Acquired with a Topcon TRC-NW8 · centered on the macula:
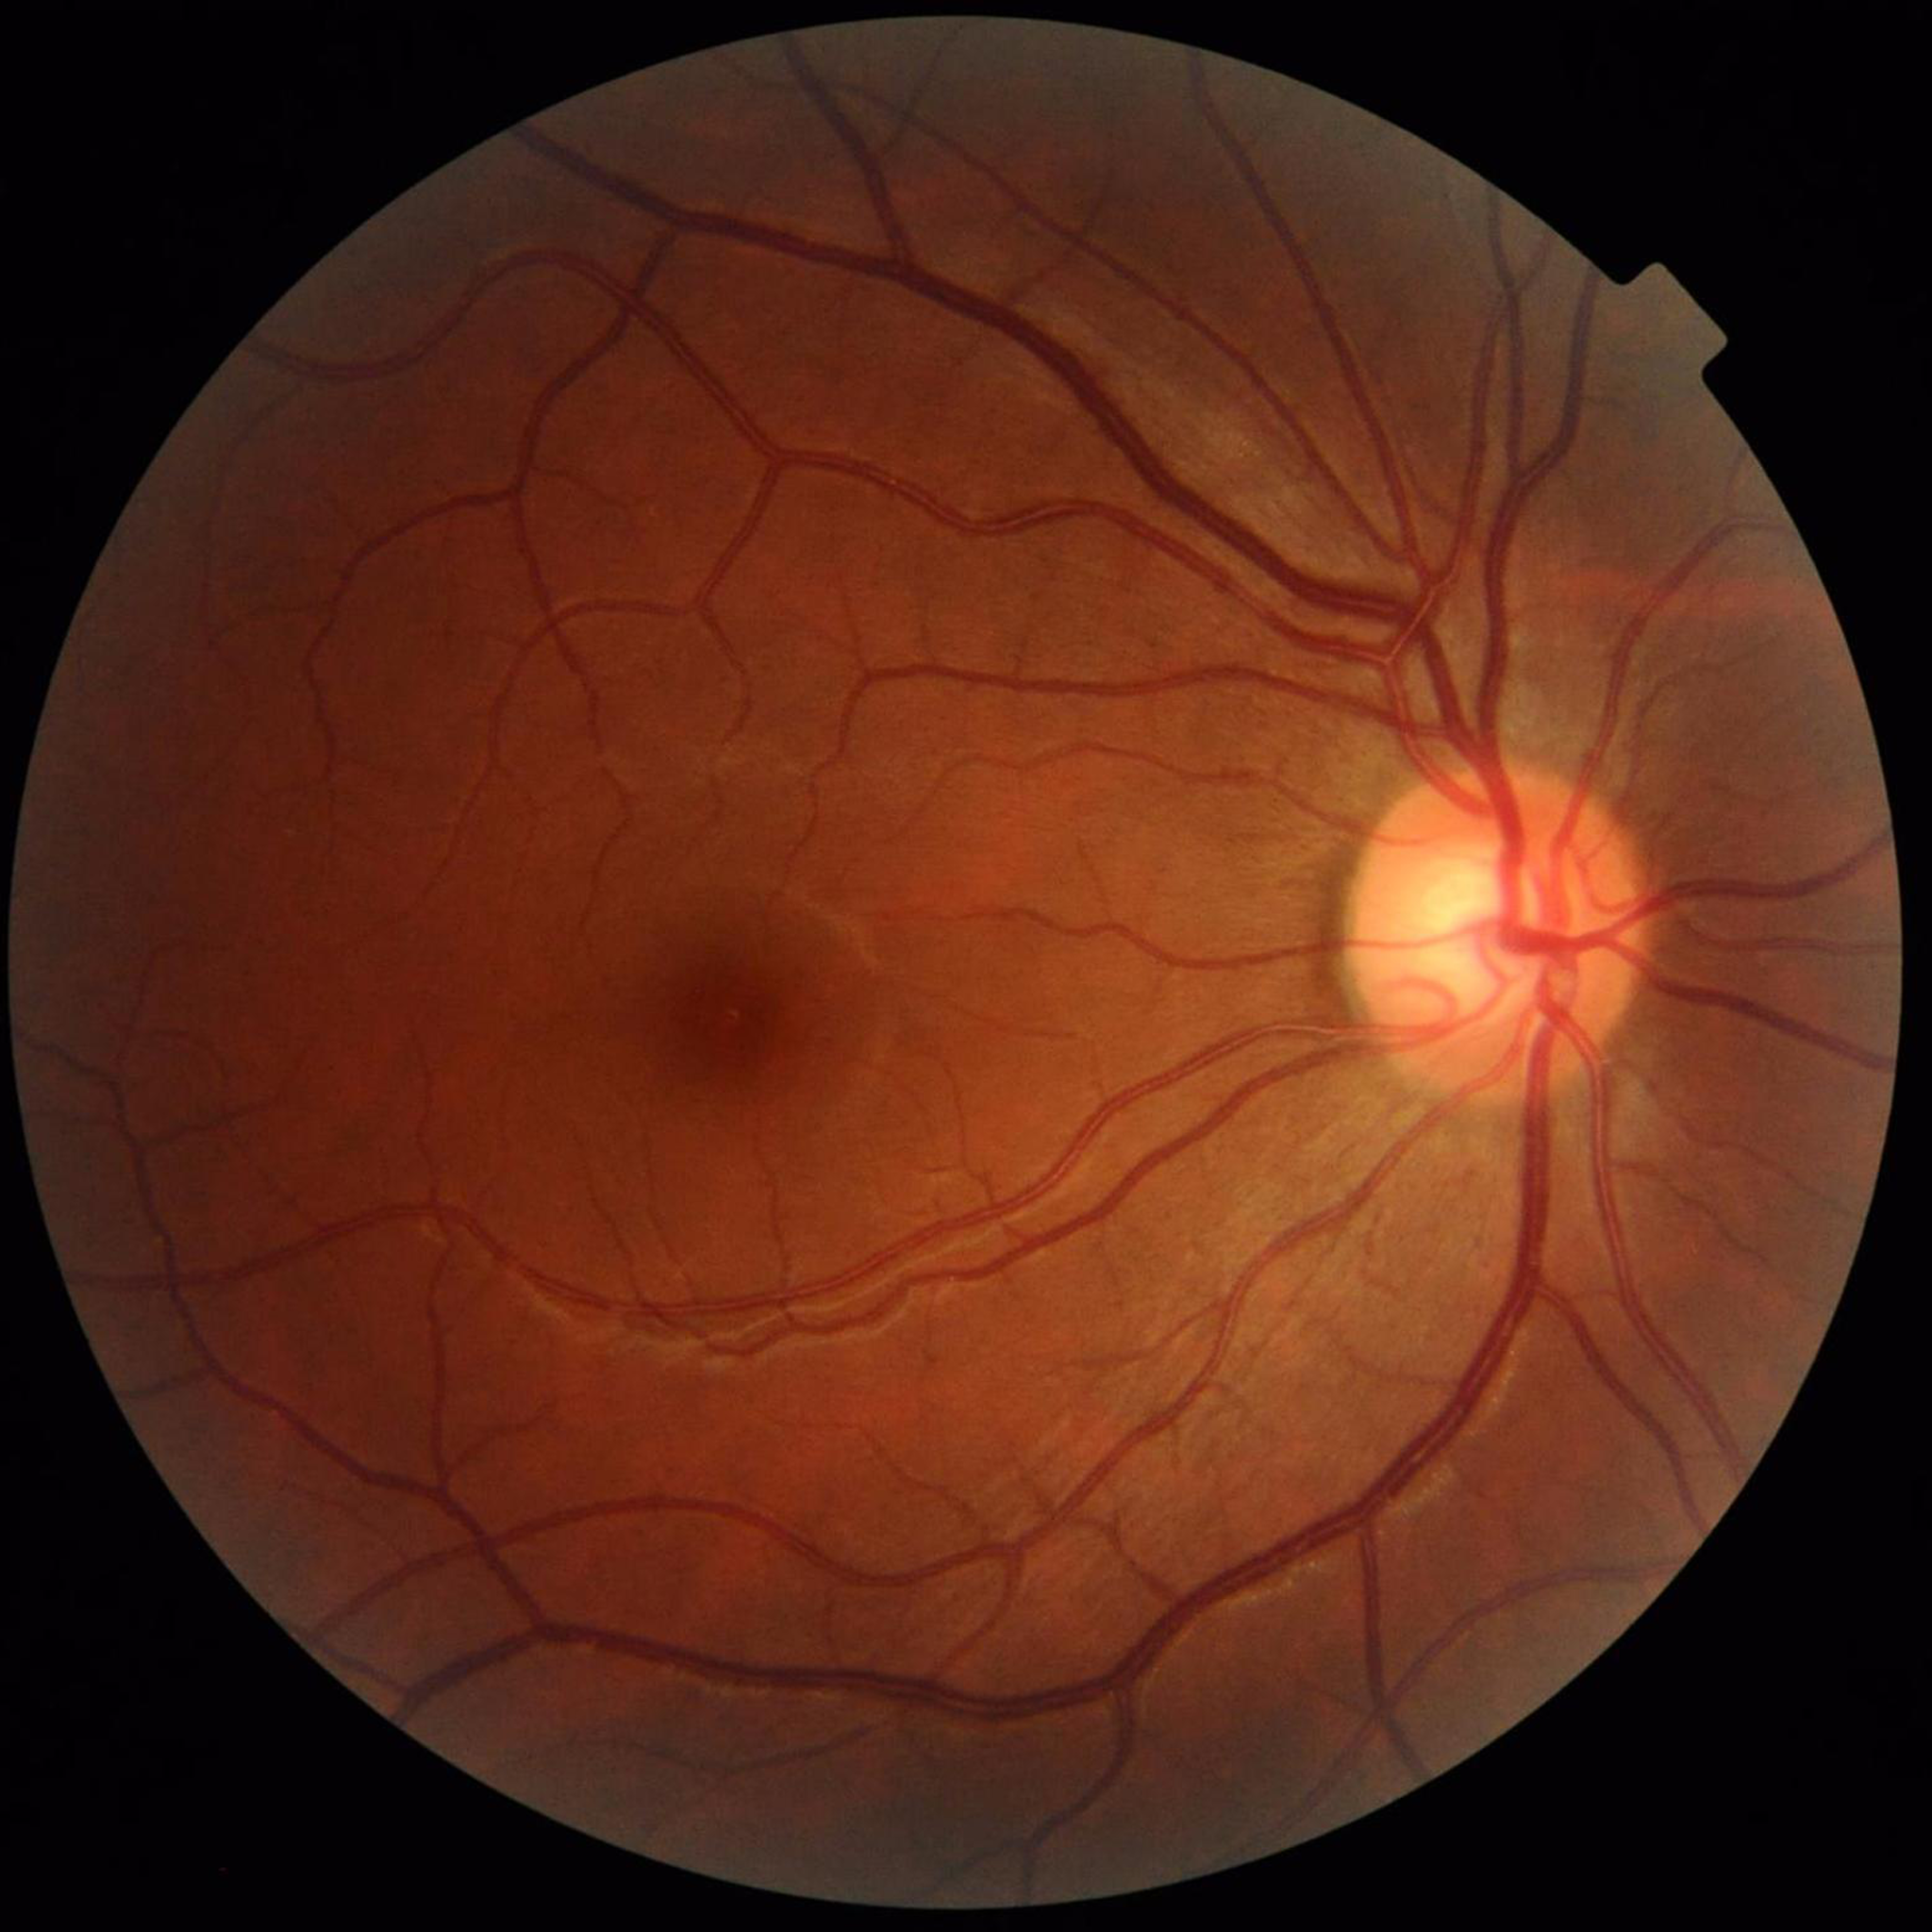 Disease class: glaucoma.